Acquired on the Clarity RetCam 3 · wide-field fundus photograph of an infant:
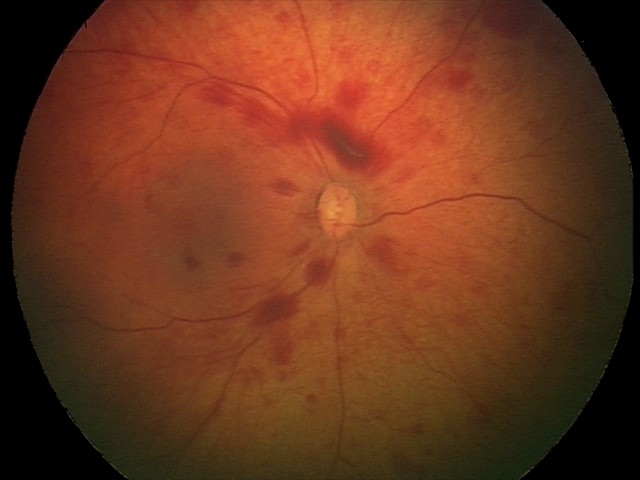 Q: What is the screening diagnosis?
A: retinal hemorrhages